640 x 480 pixels · infant wide-field fundus photograph — 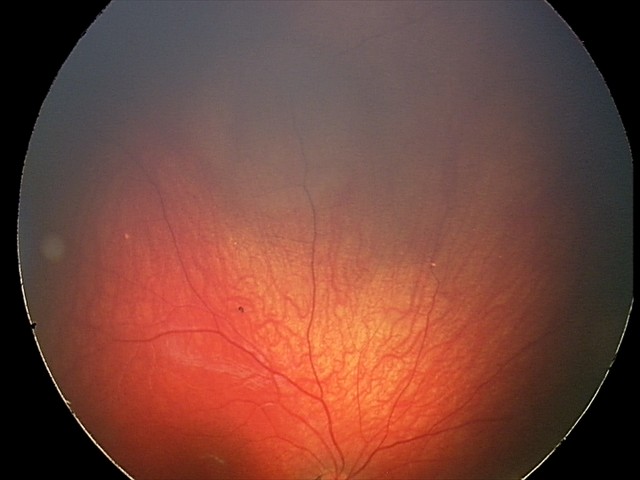 Q: What is the screening diagnosis?
A: retinal astrocytic hamartoma